848x848
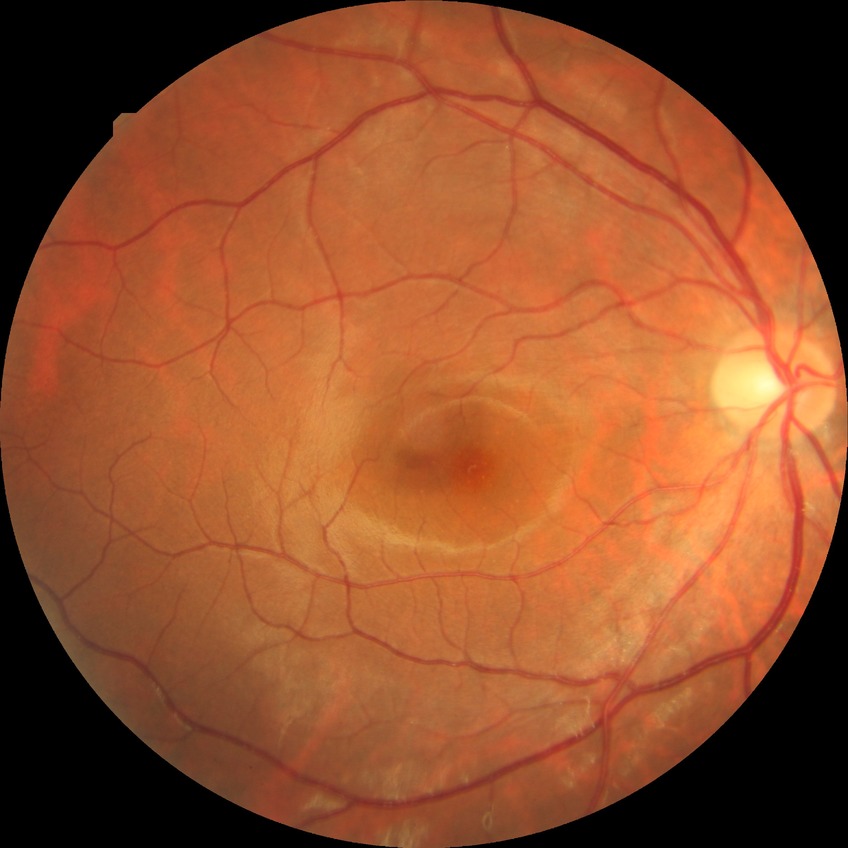 Diabetic retinopathy (DR): NDR (no diabetic retinopathy).